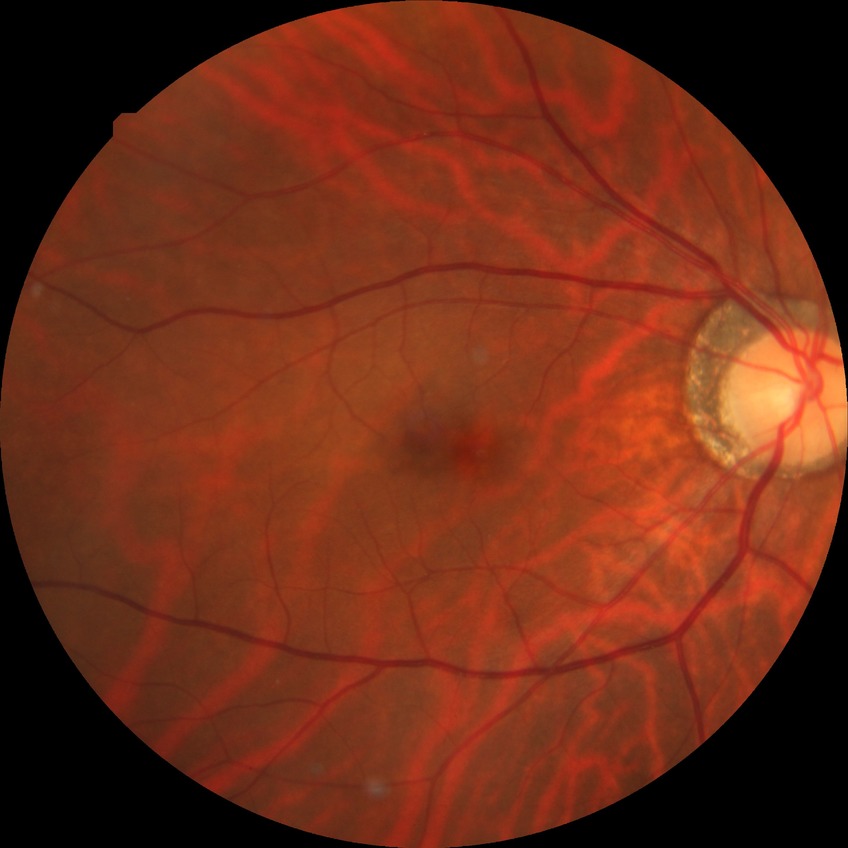 Retinopathy stage: no diabetic retinopathy.